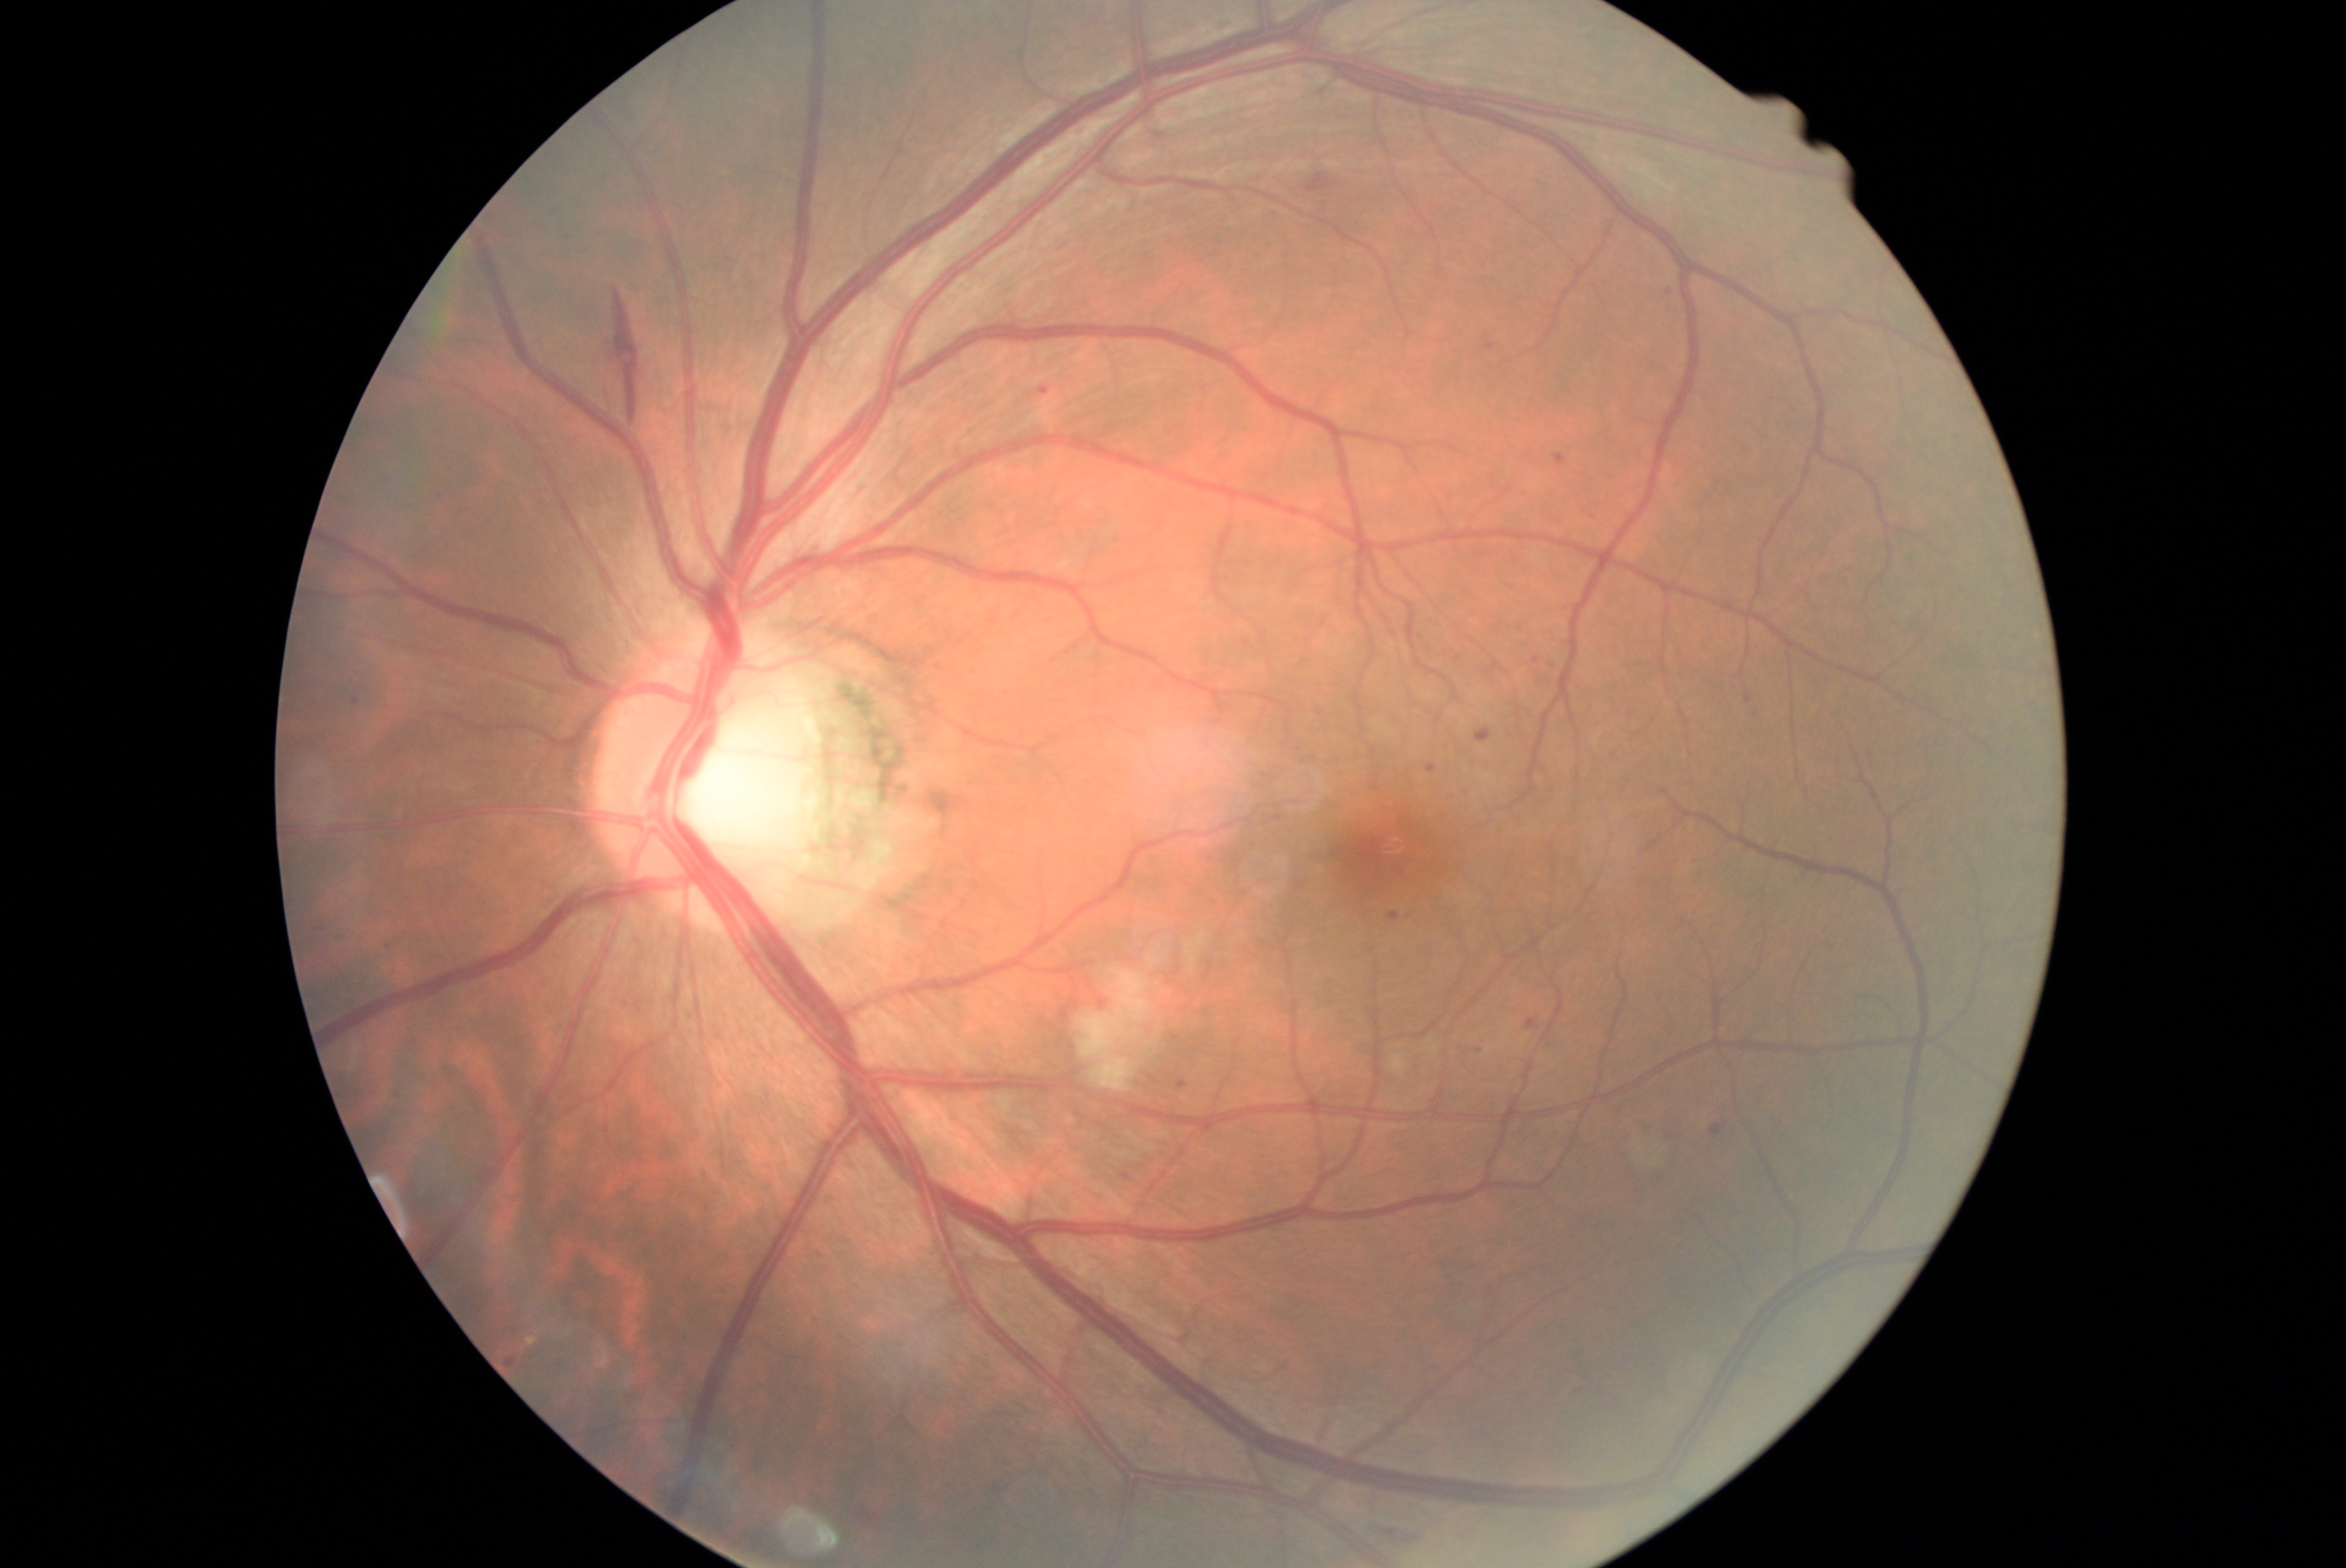

The retinopathy is classified as non-proliferative diabetic retinopathy. Diabetic retinopathy (DR) is 2.